Captured with the Phoenix ICON (100° field of view); infant wide-field fundus photograph; 1240x1240px:
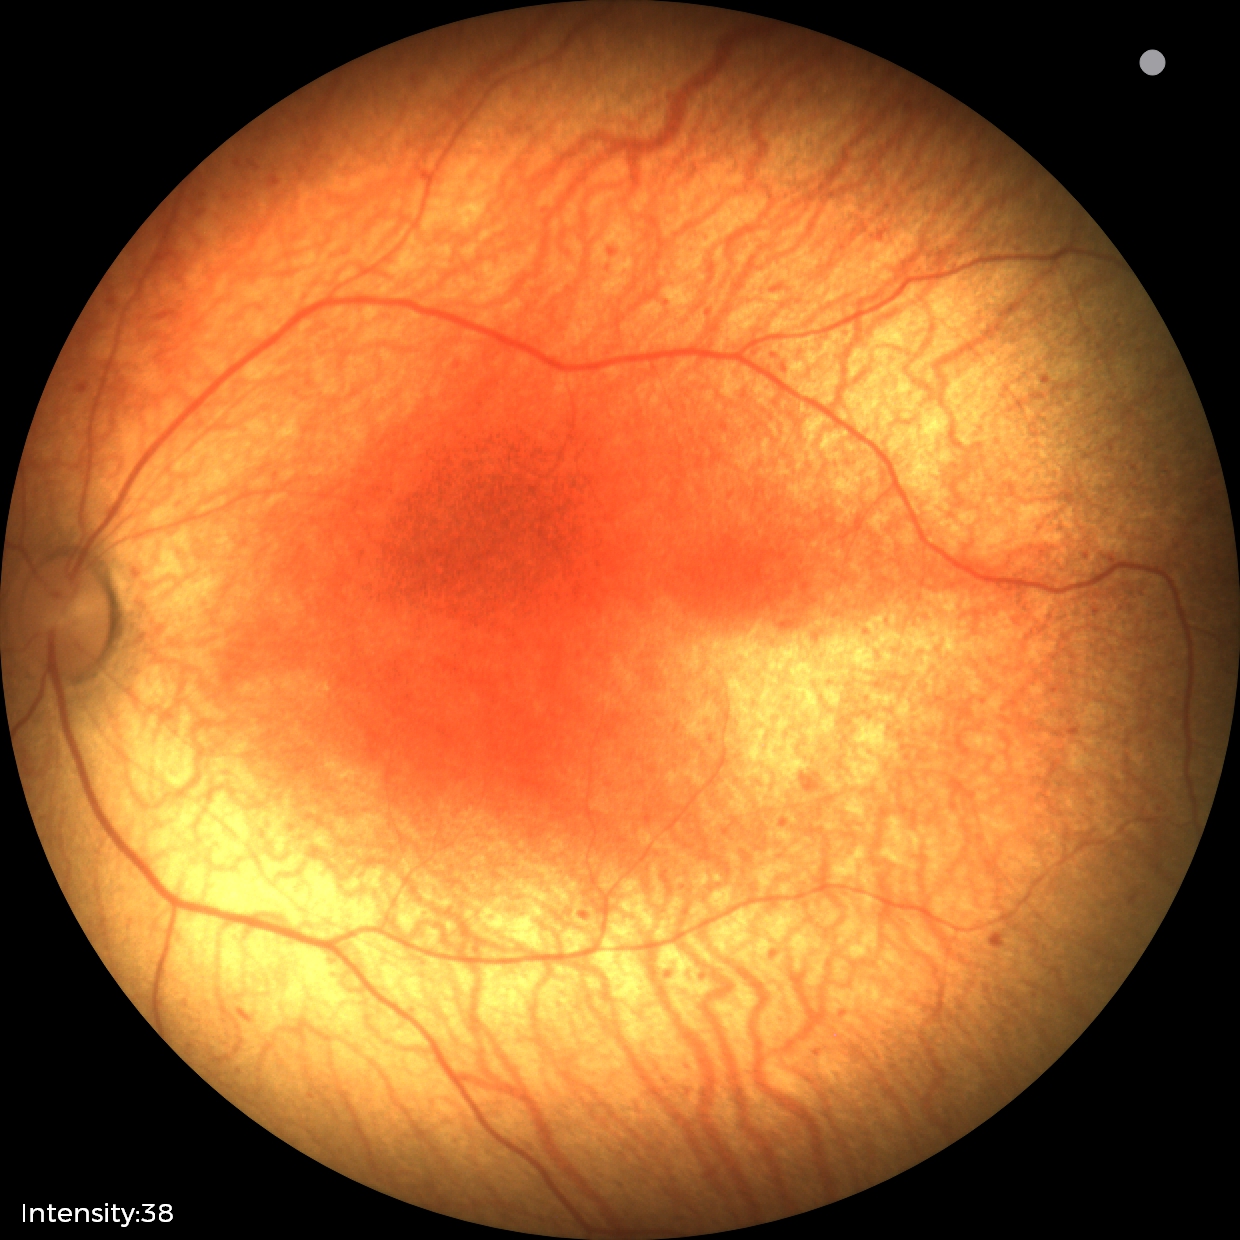

Without plus disease.
From an examination with diagnosis of status post retinopathy of prematurity (ROP).